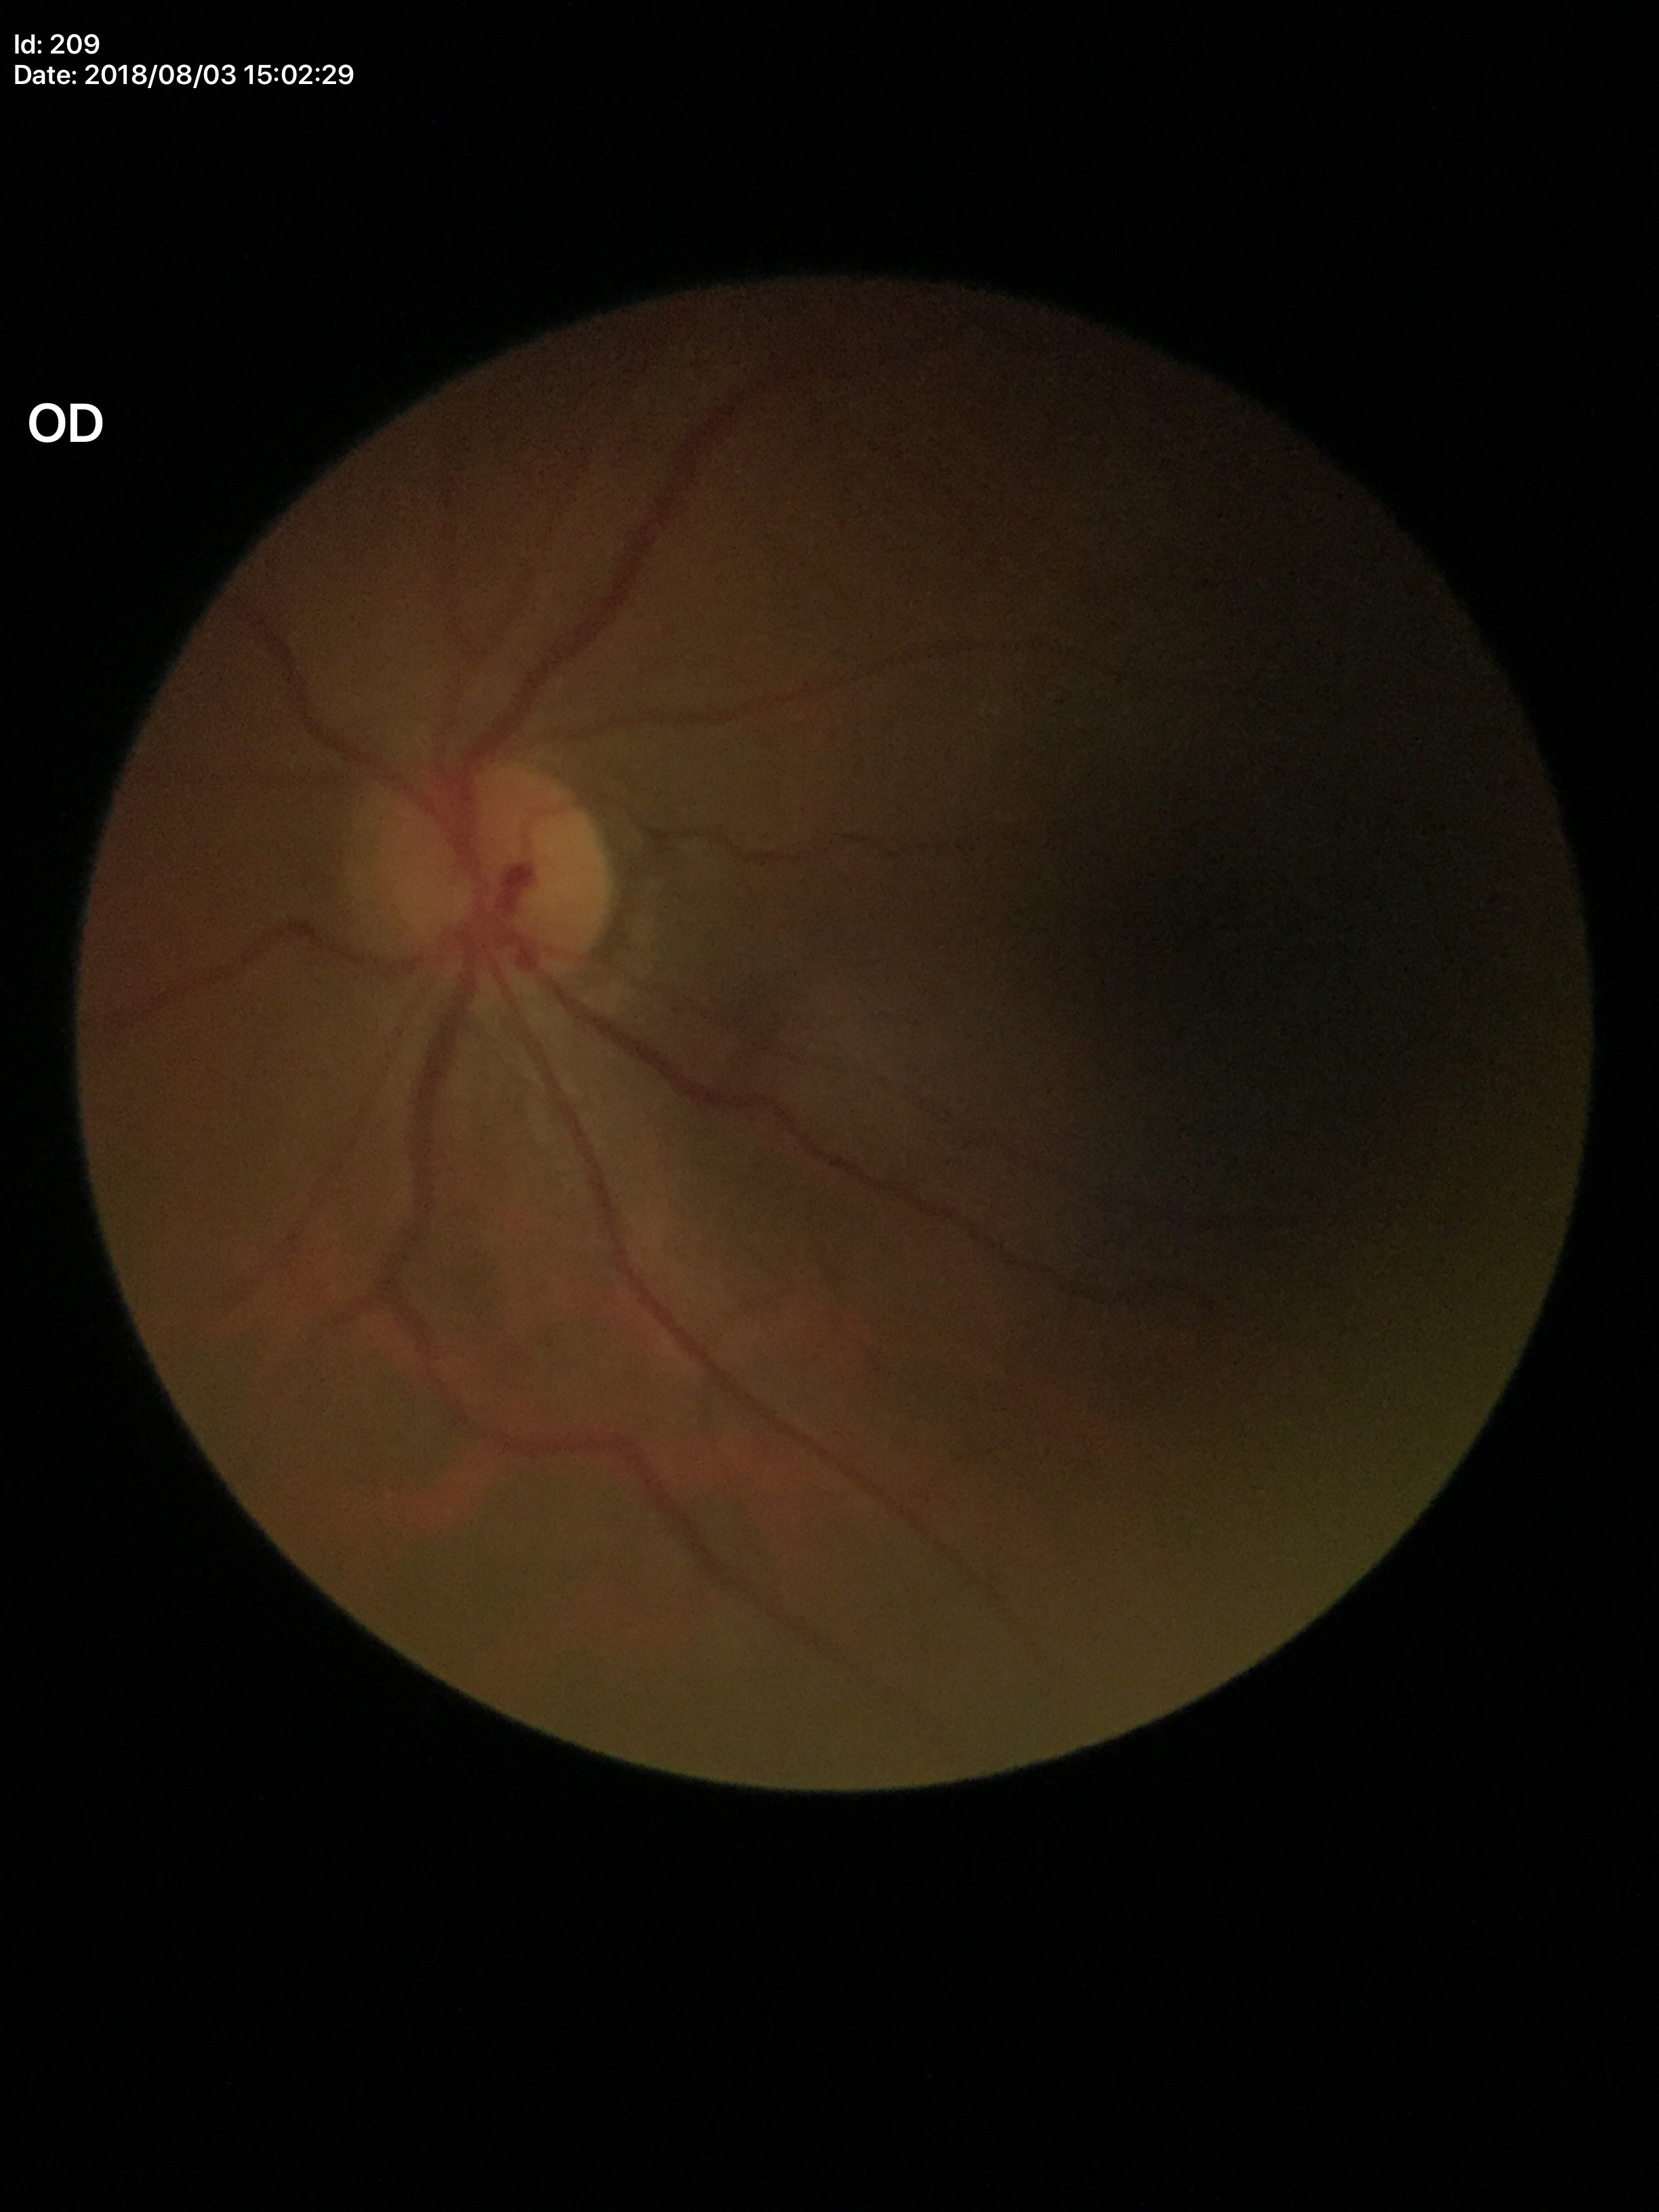 horizontal CDR (HCDR) = 0.40 | Glaucoma screening impression = no suspicious findings (unanimous normal call) | vertical C/D ratio (VCDR) = 0.41.